Infant wide-field fundus photograph · image size 640x480 · acquired on the Clarity RetCam 3 — 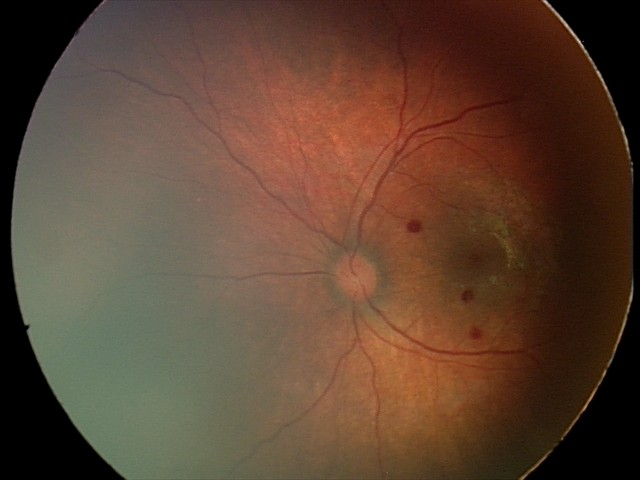

Q: What is the screening diagnosis?
A: retinal hemorrhages